848 by 848 pixels
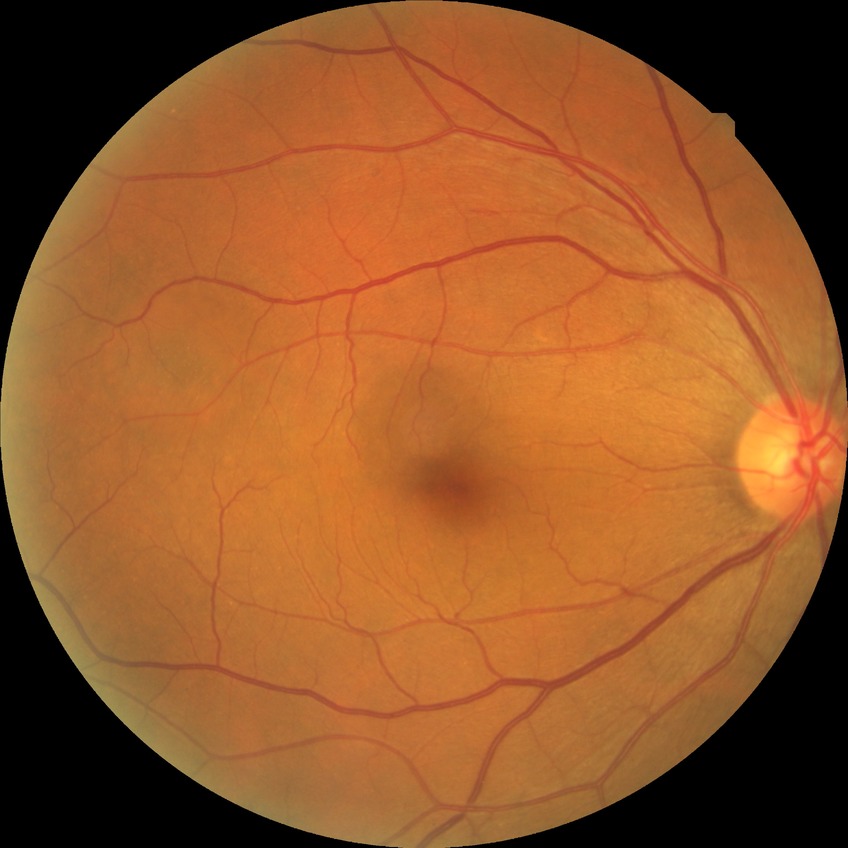 davis_grade: no diabetic retinopathy (NDR)